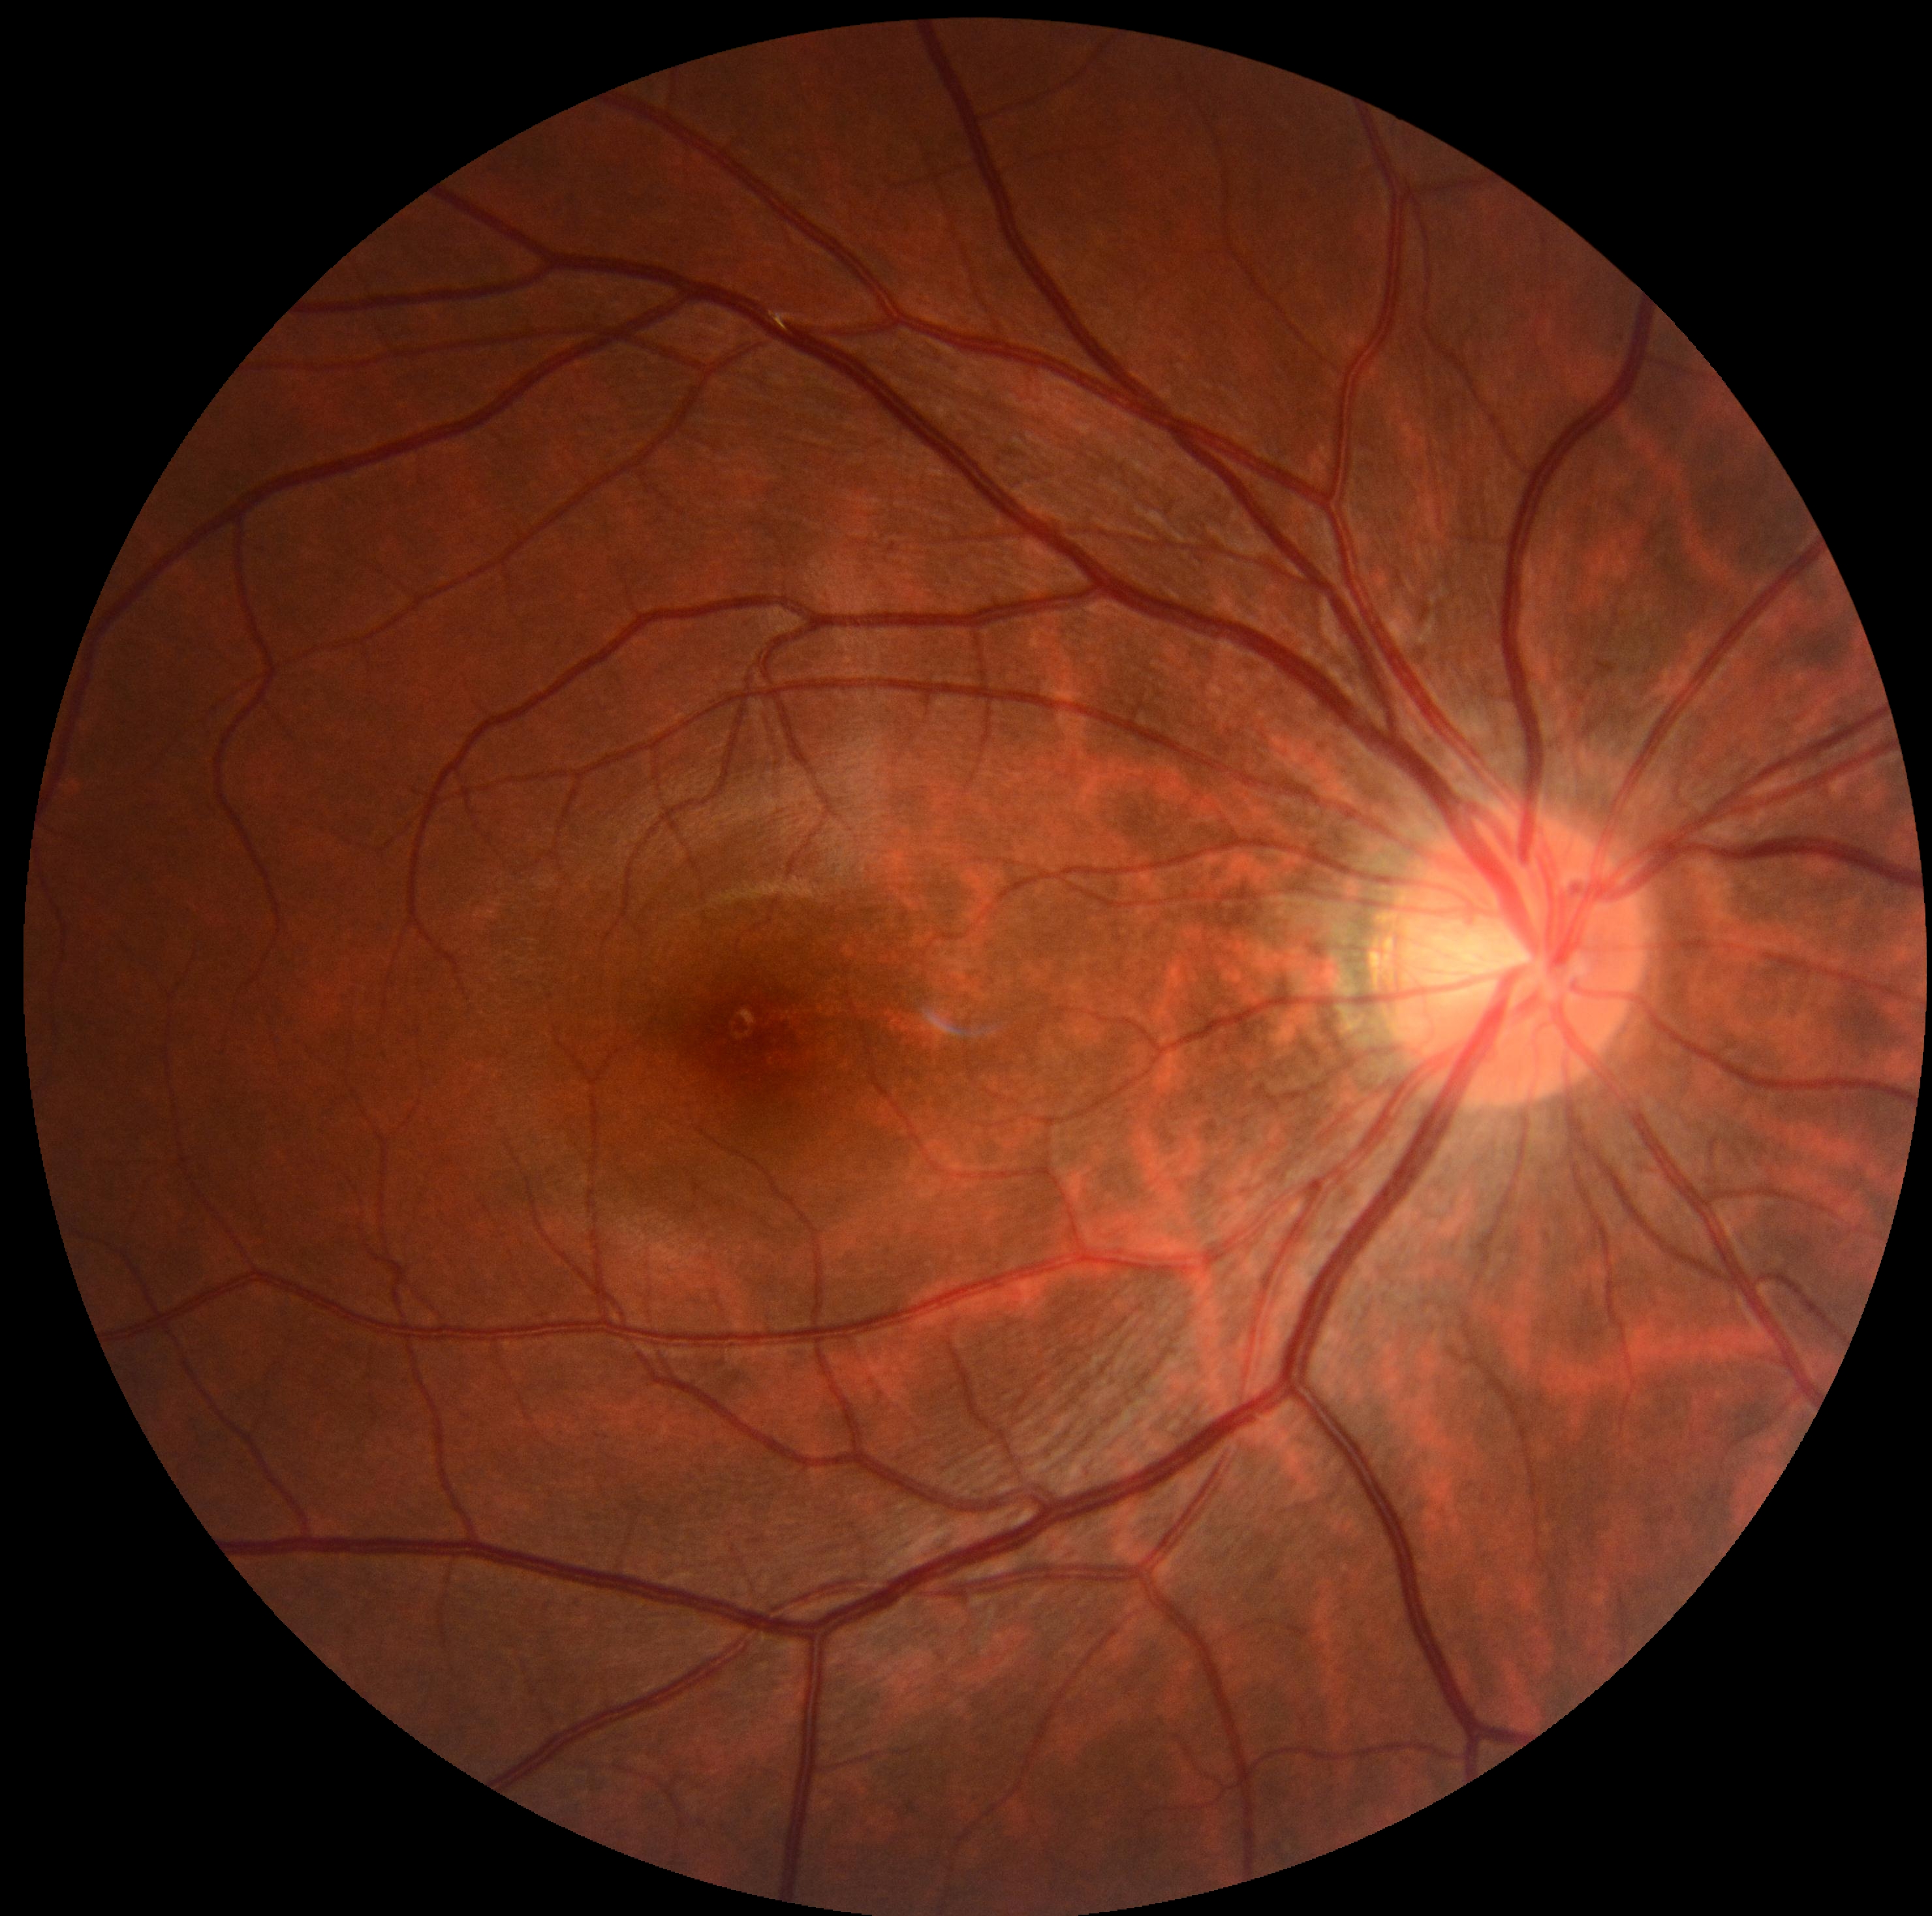

– retinopathy grade: no apparent diabetic retinopathy (0)